Wide-field fundus image from infant ROP screening
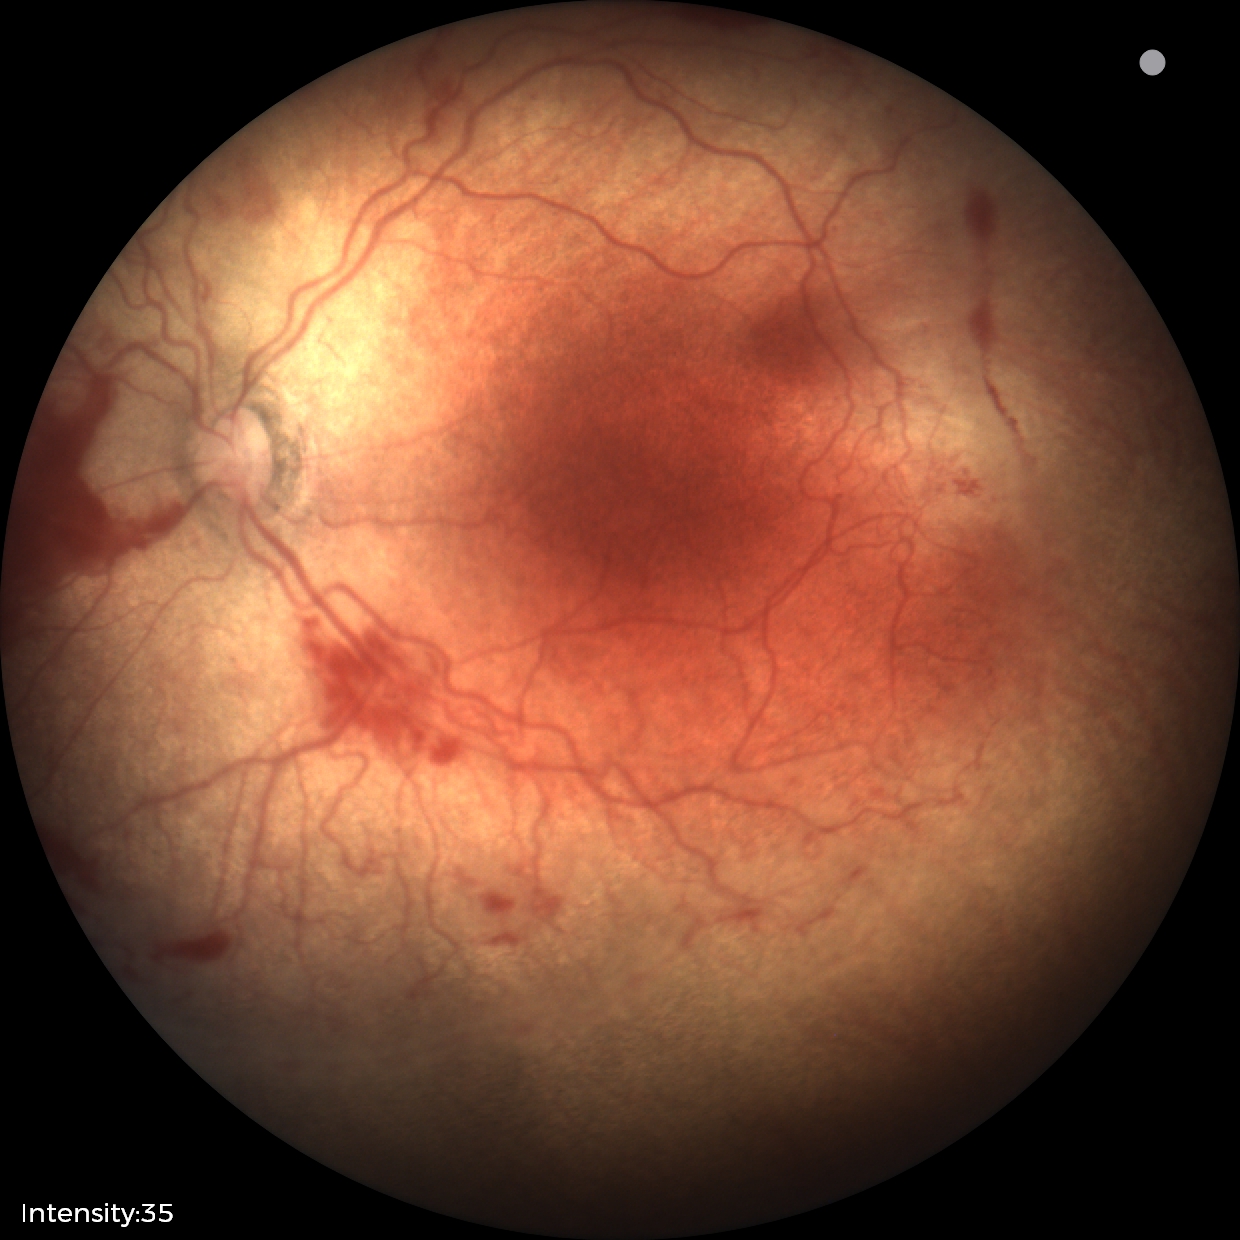 With plus disease. Examination diagnosed as retinopathy of prematurity (ROP) stage 2.